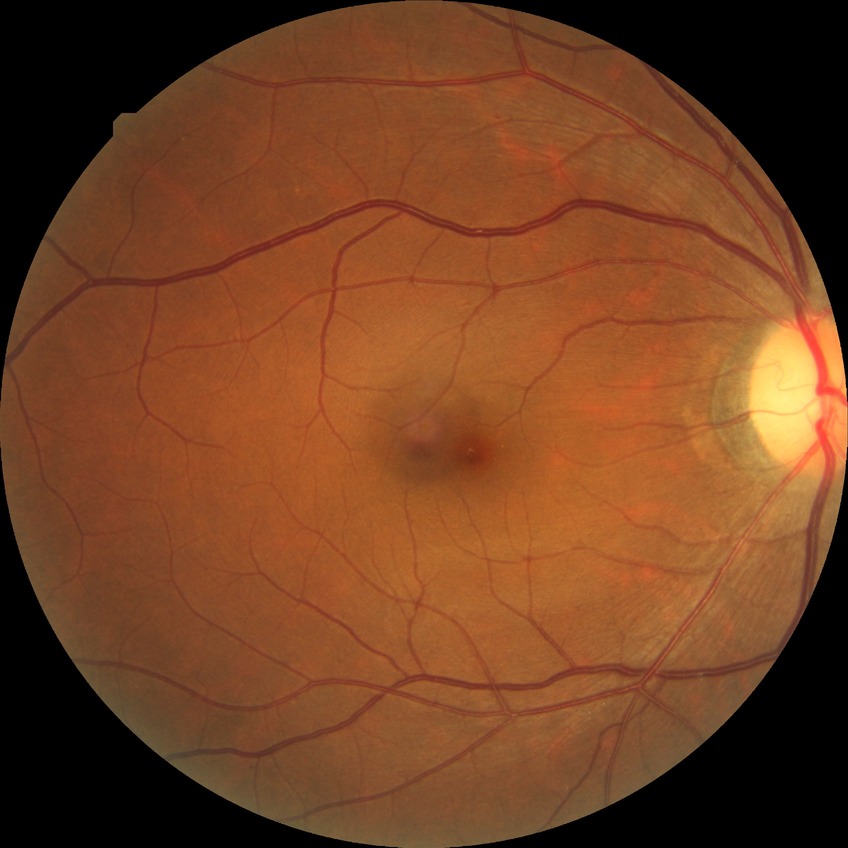

Davis grading: no diabetic retinopathy.